Wide-field fundus image from infant ROP screening. Image size 1440x1080 — 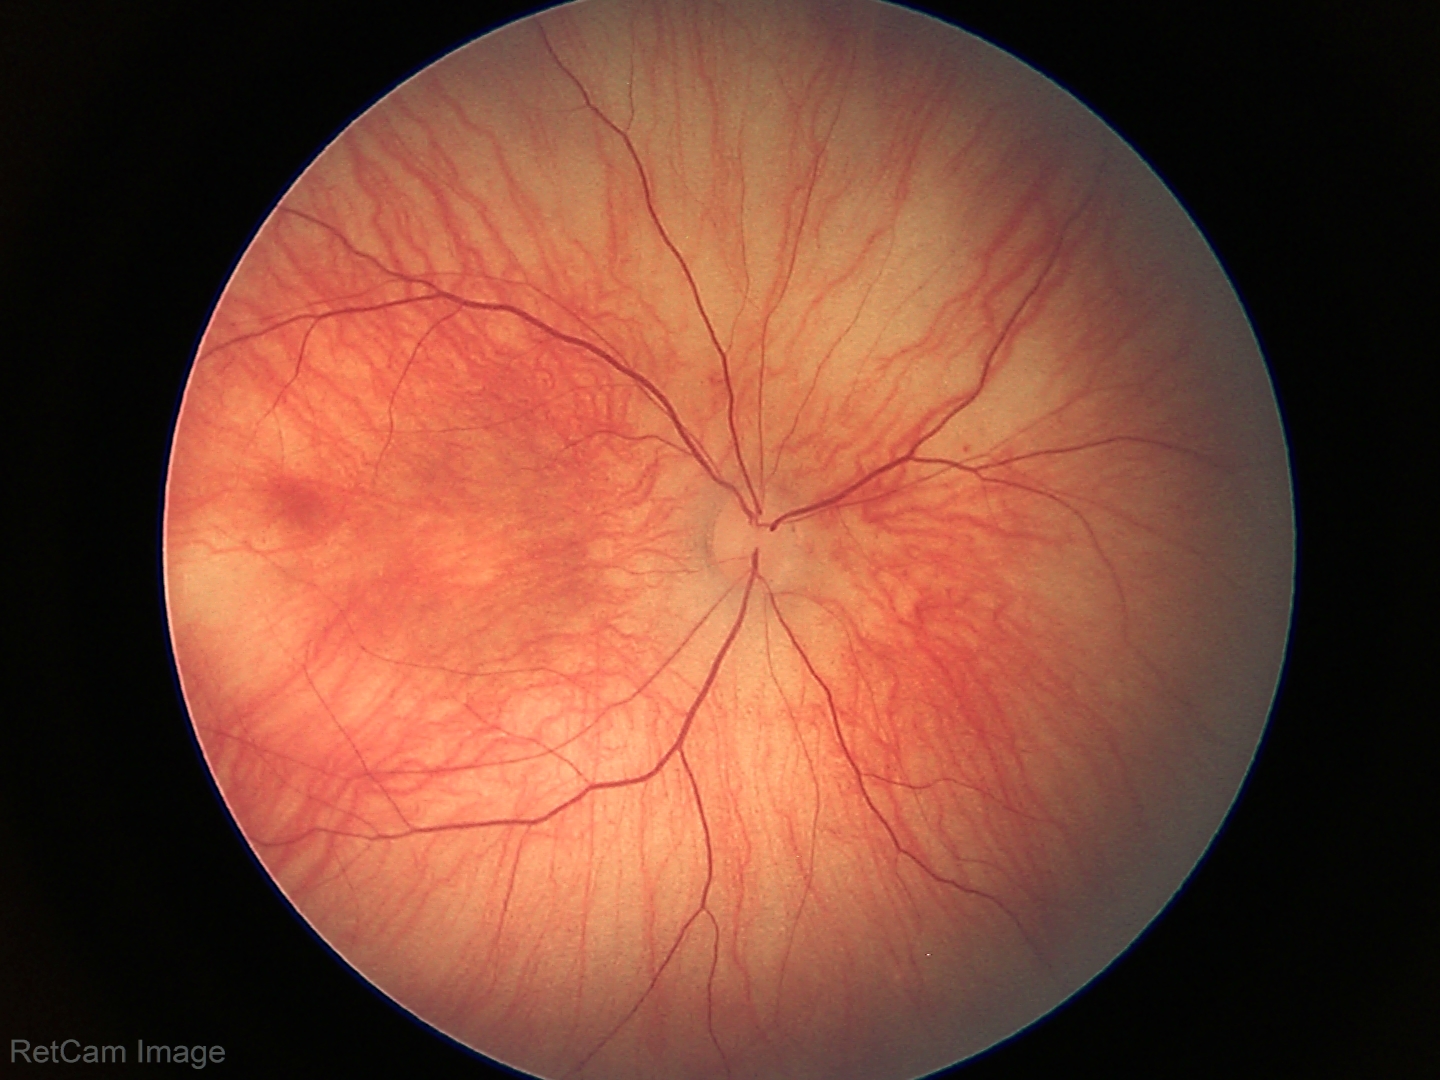 No retinal pathology identified on screening.